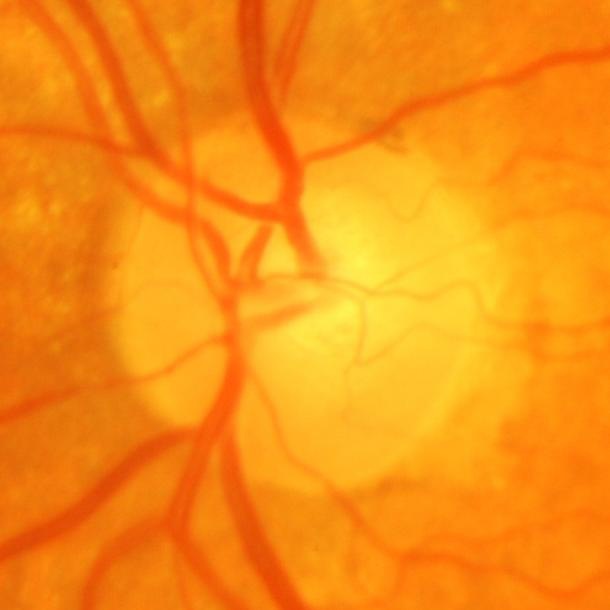 Glaucomatous optic neuropathy.